2048x1536, color fundus image:
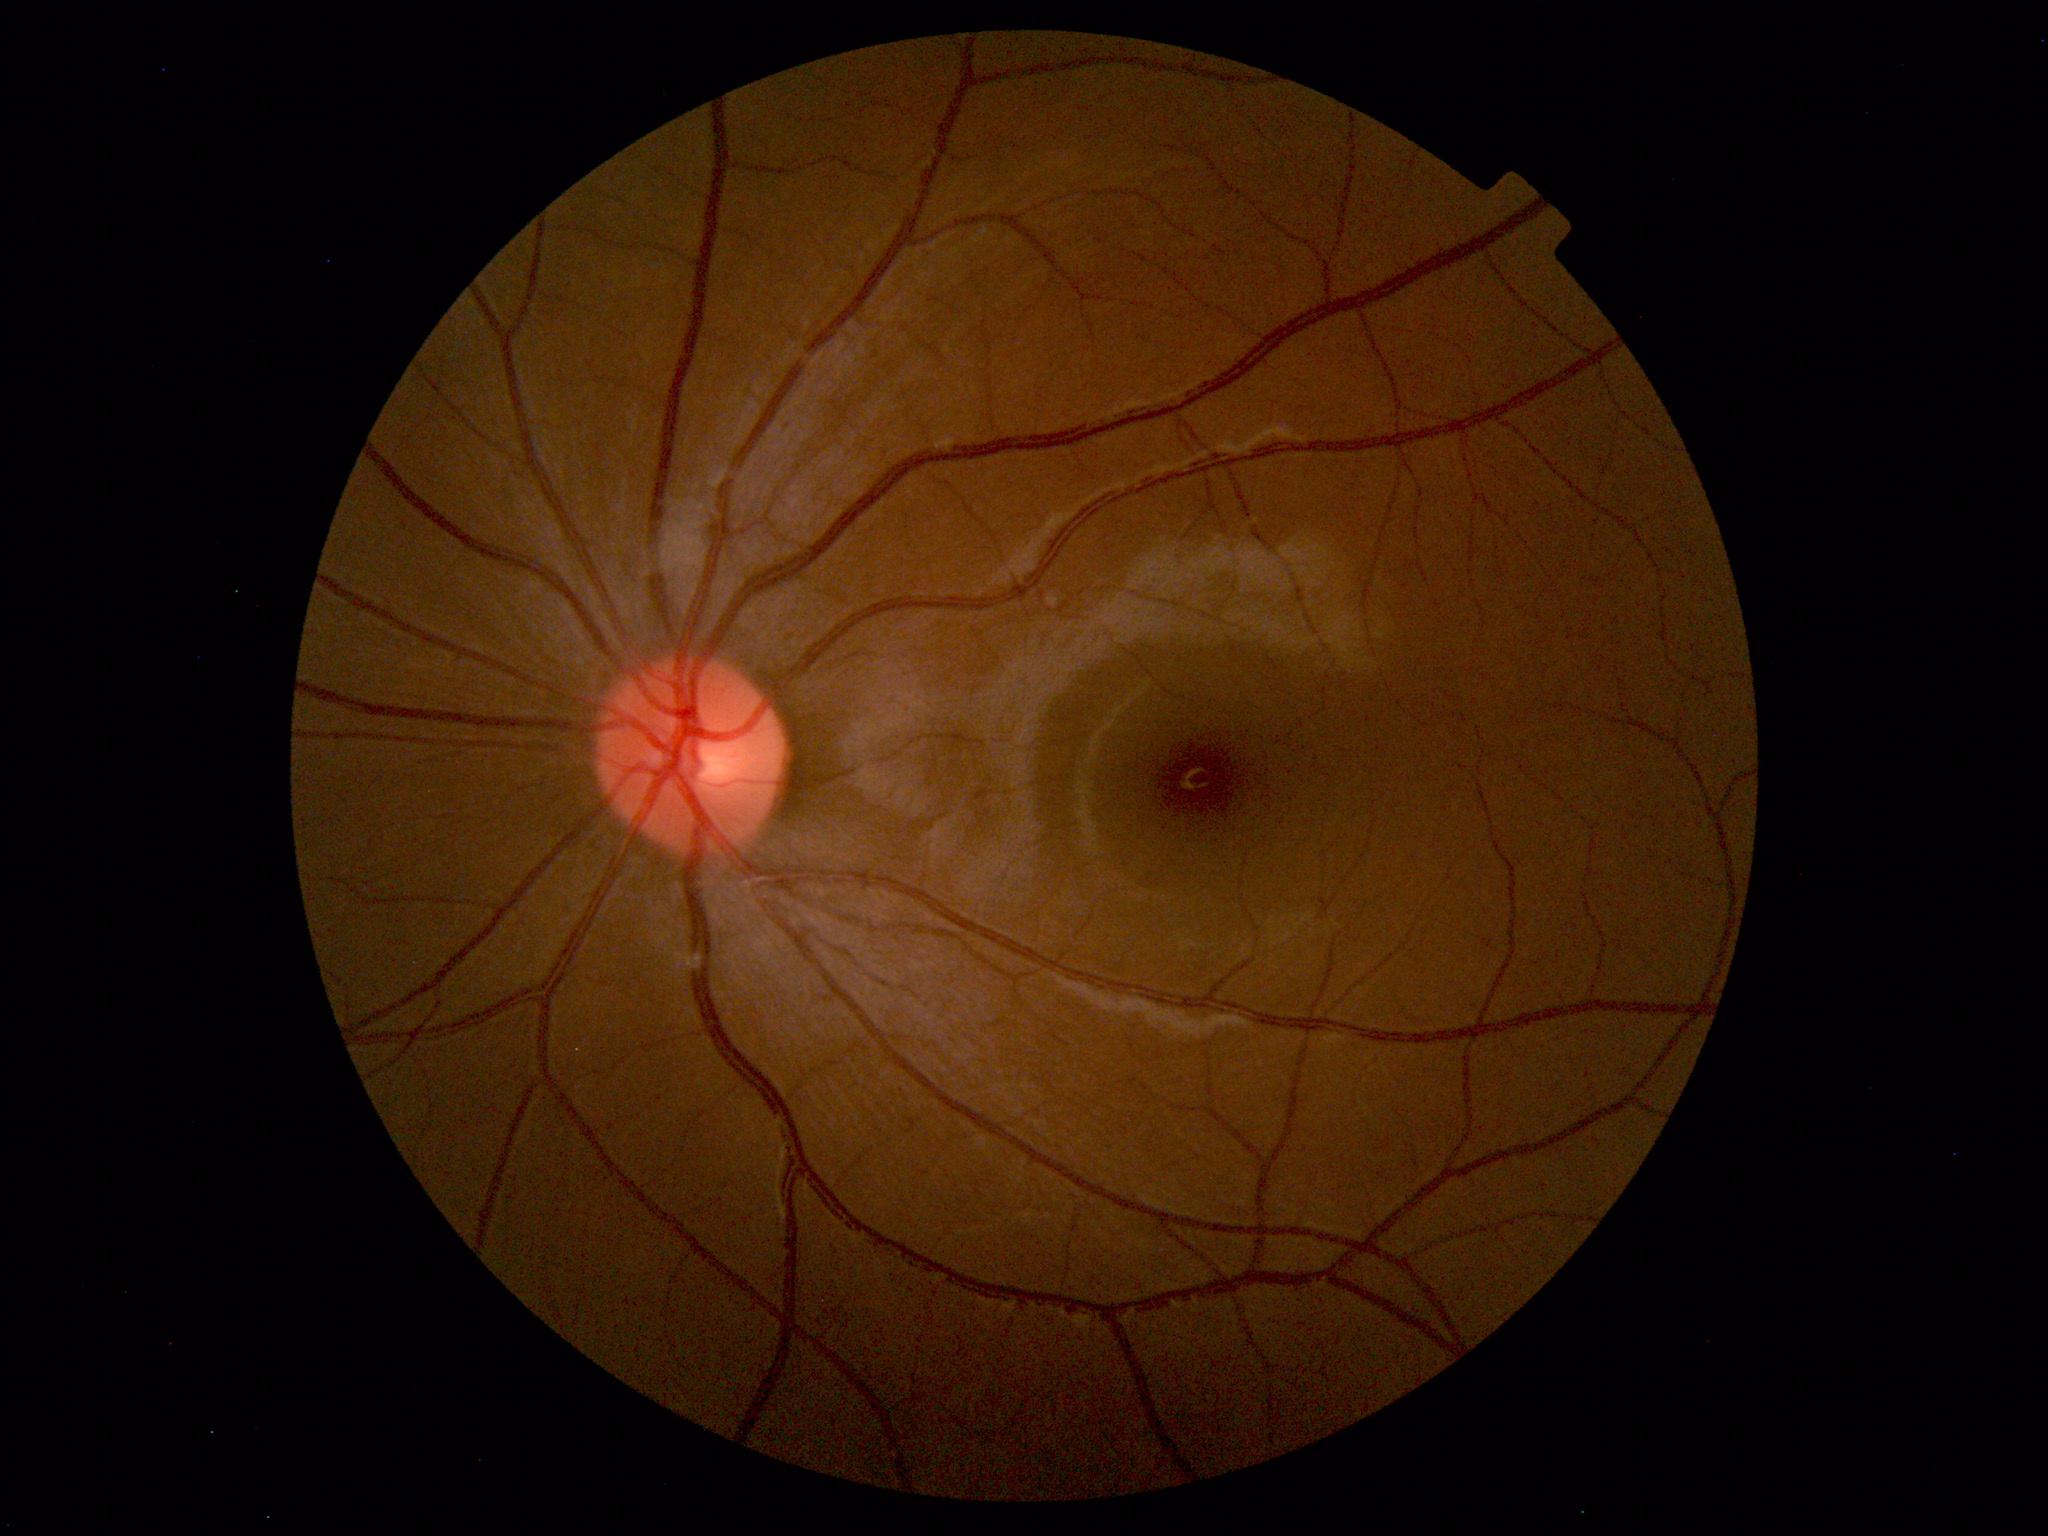
Findings: no abnormalities.